FOV: 45 degrees. Acquired with a NIDEK AFC-230. Nonmydriatic fundus photograph. CFP: 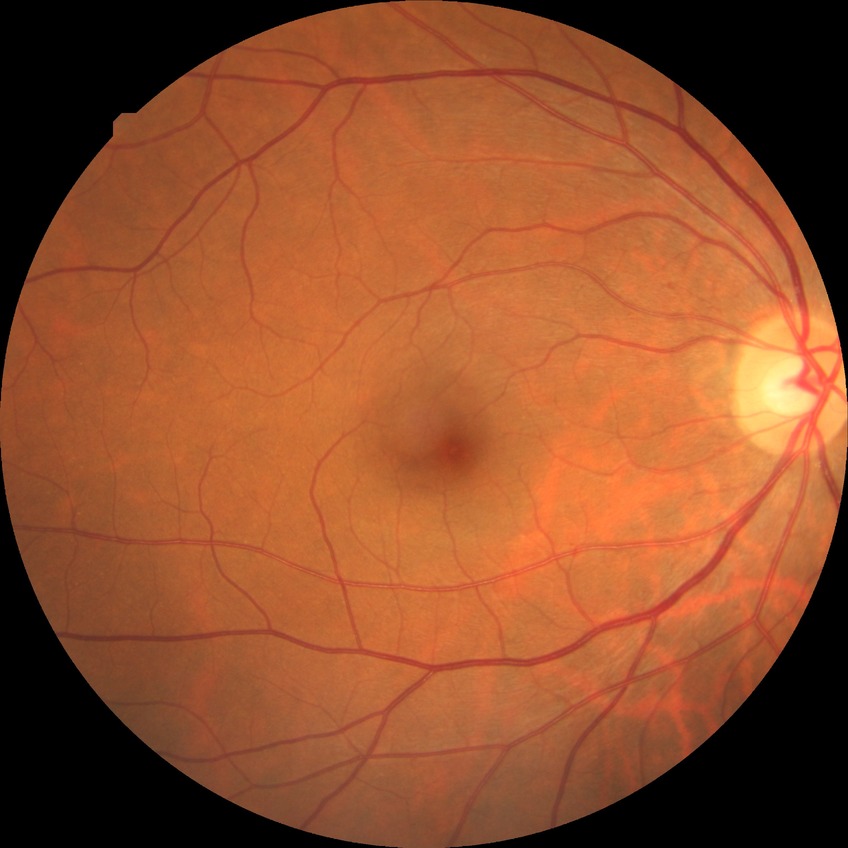 • diabetic retinopathy (DR): no diabetic retinopathy (NDR)